45° field of view — 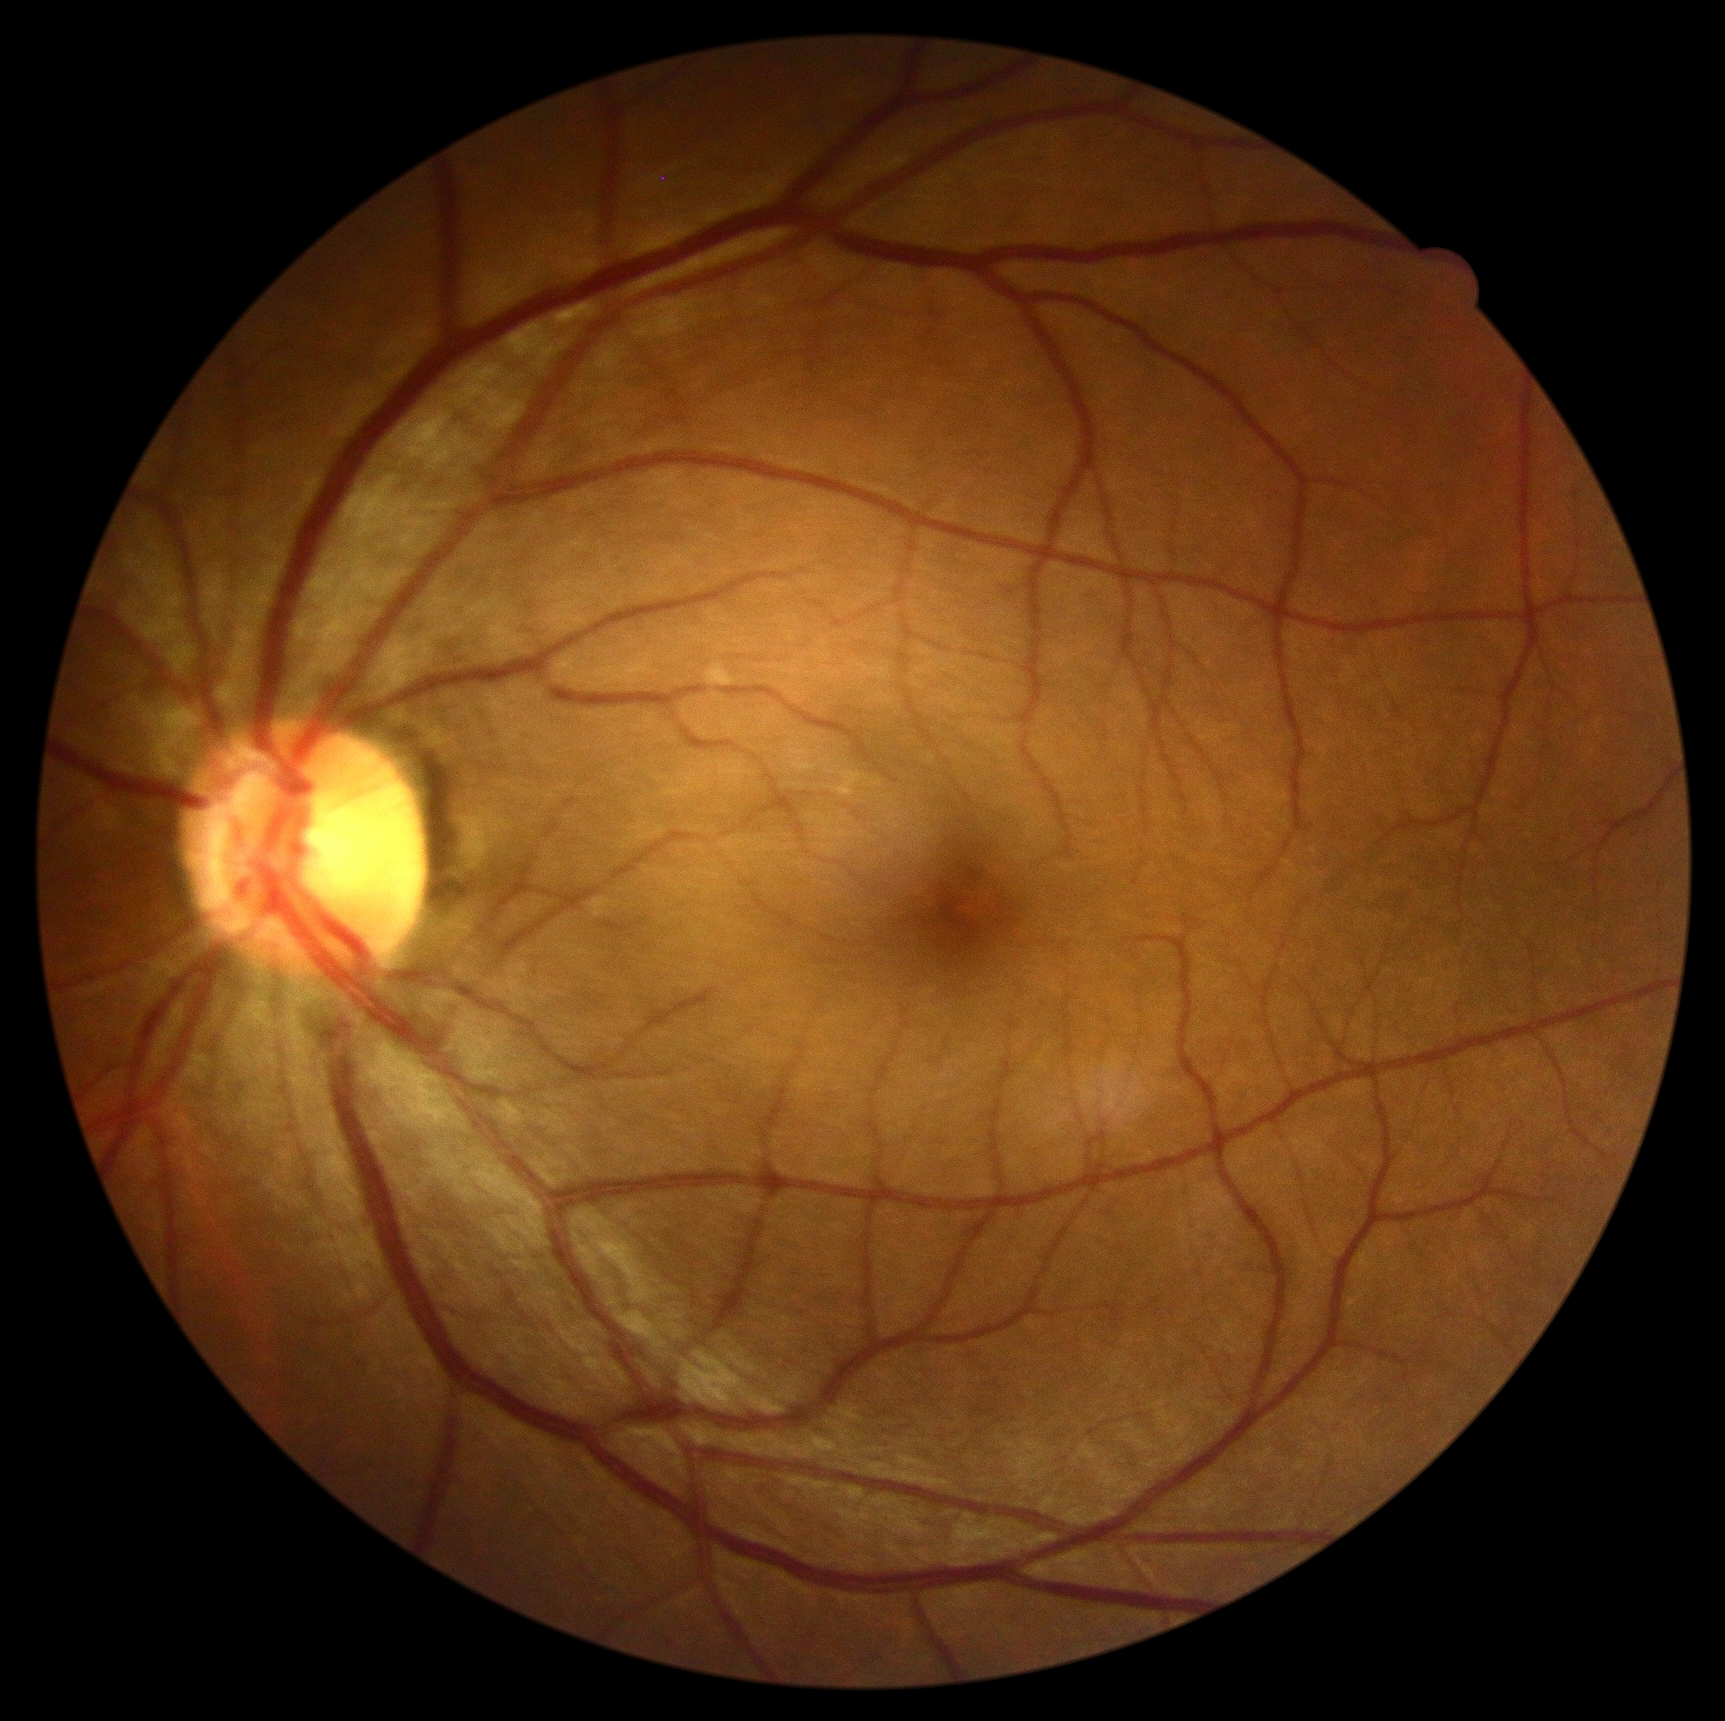

Diabetic retinopathy (DR): 0.